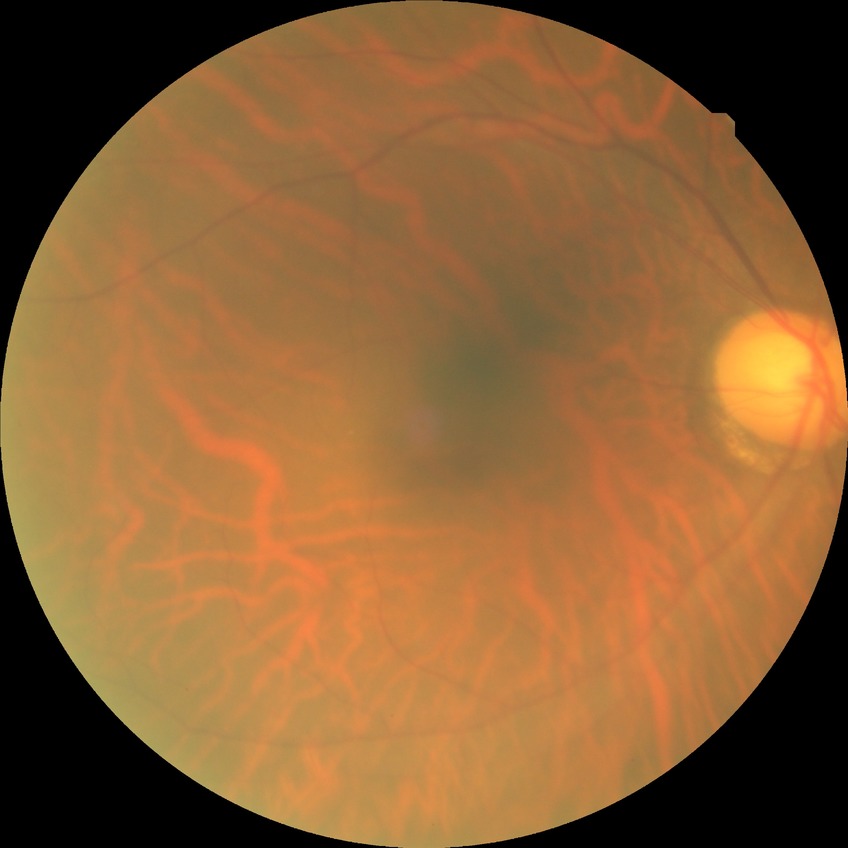 diabetic retinopathy grade: no diabetic retinopathy.